1240x1240. Wide-field fundus photograph of an infant
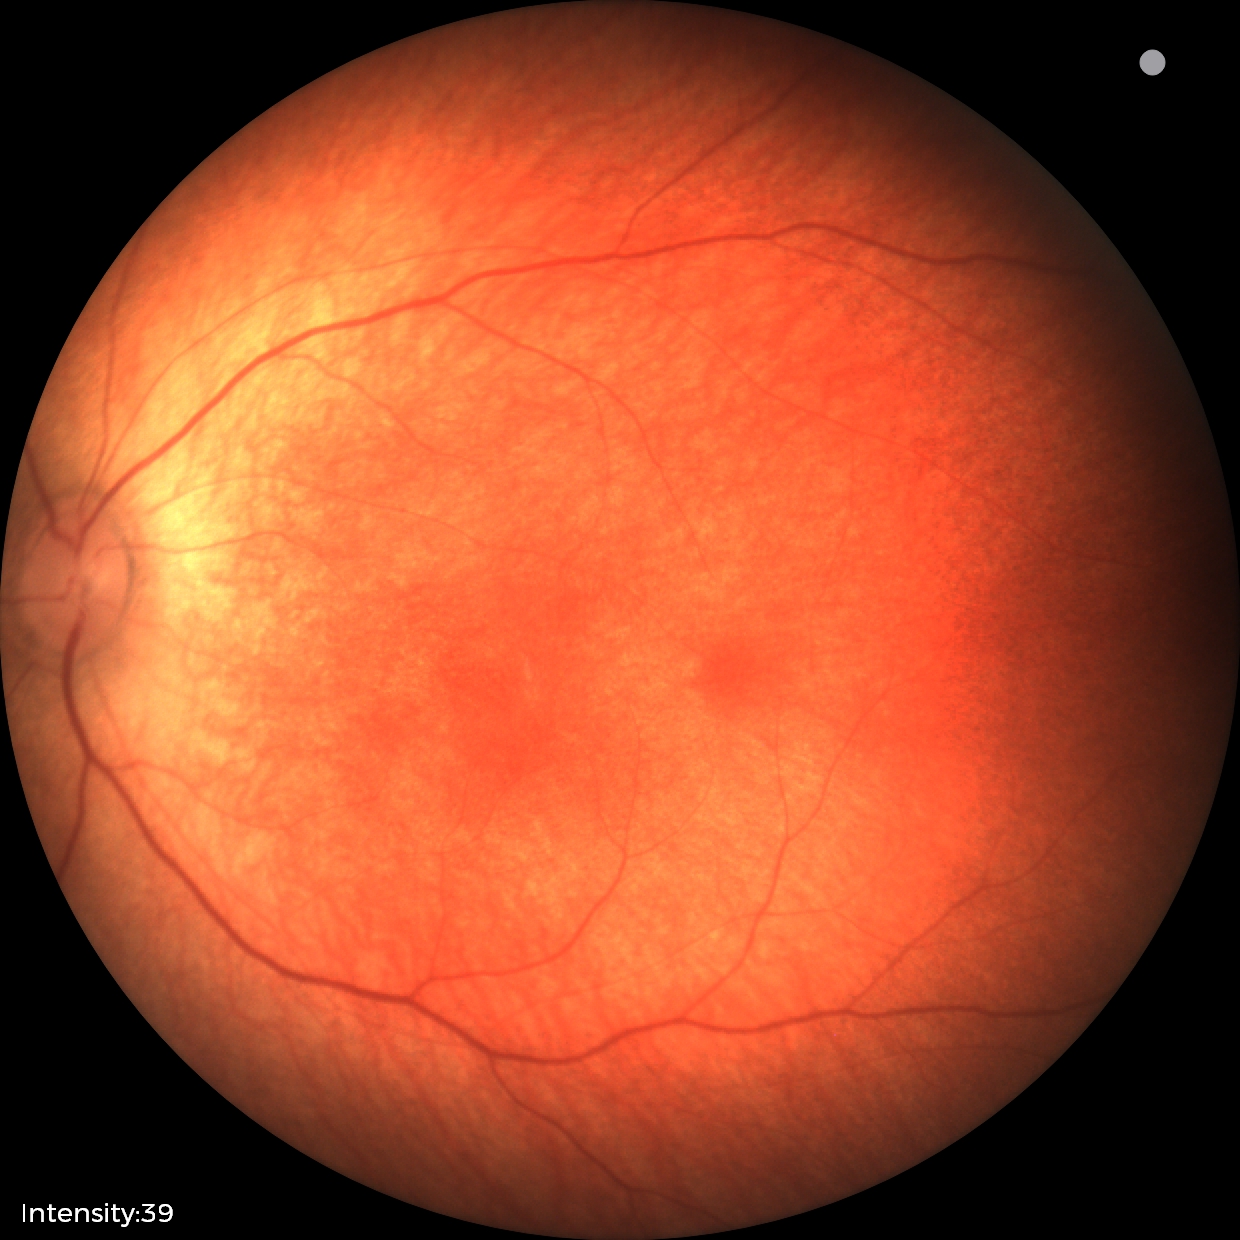

Normal screening examination.